Infant wide-field fundus photograph · camera: Clarity RetCam 3 (130° FOV) · 640 x 480 pixels — 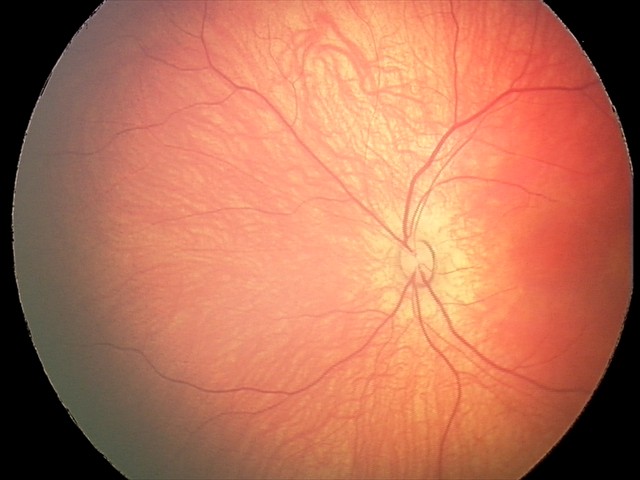

Series diagnosed as retinal hemorrhages.